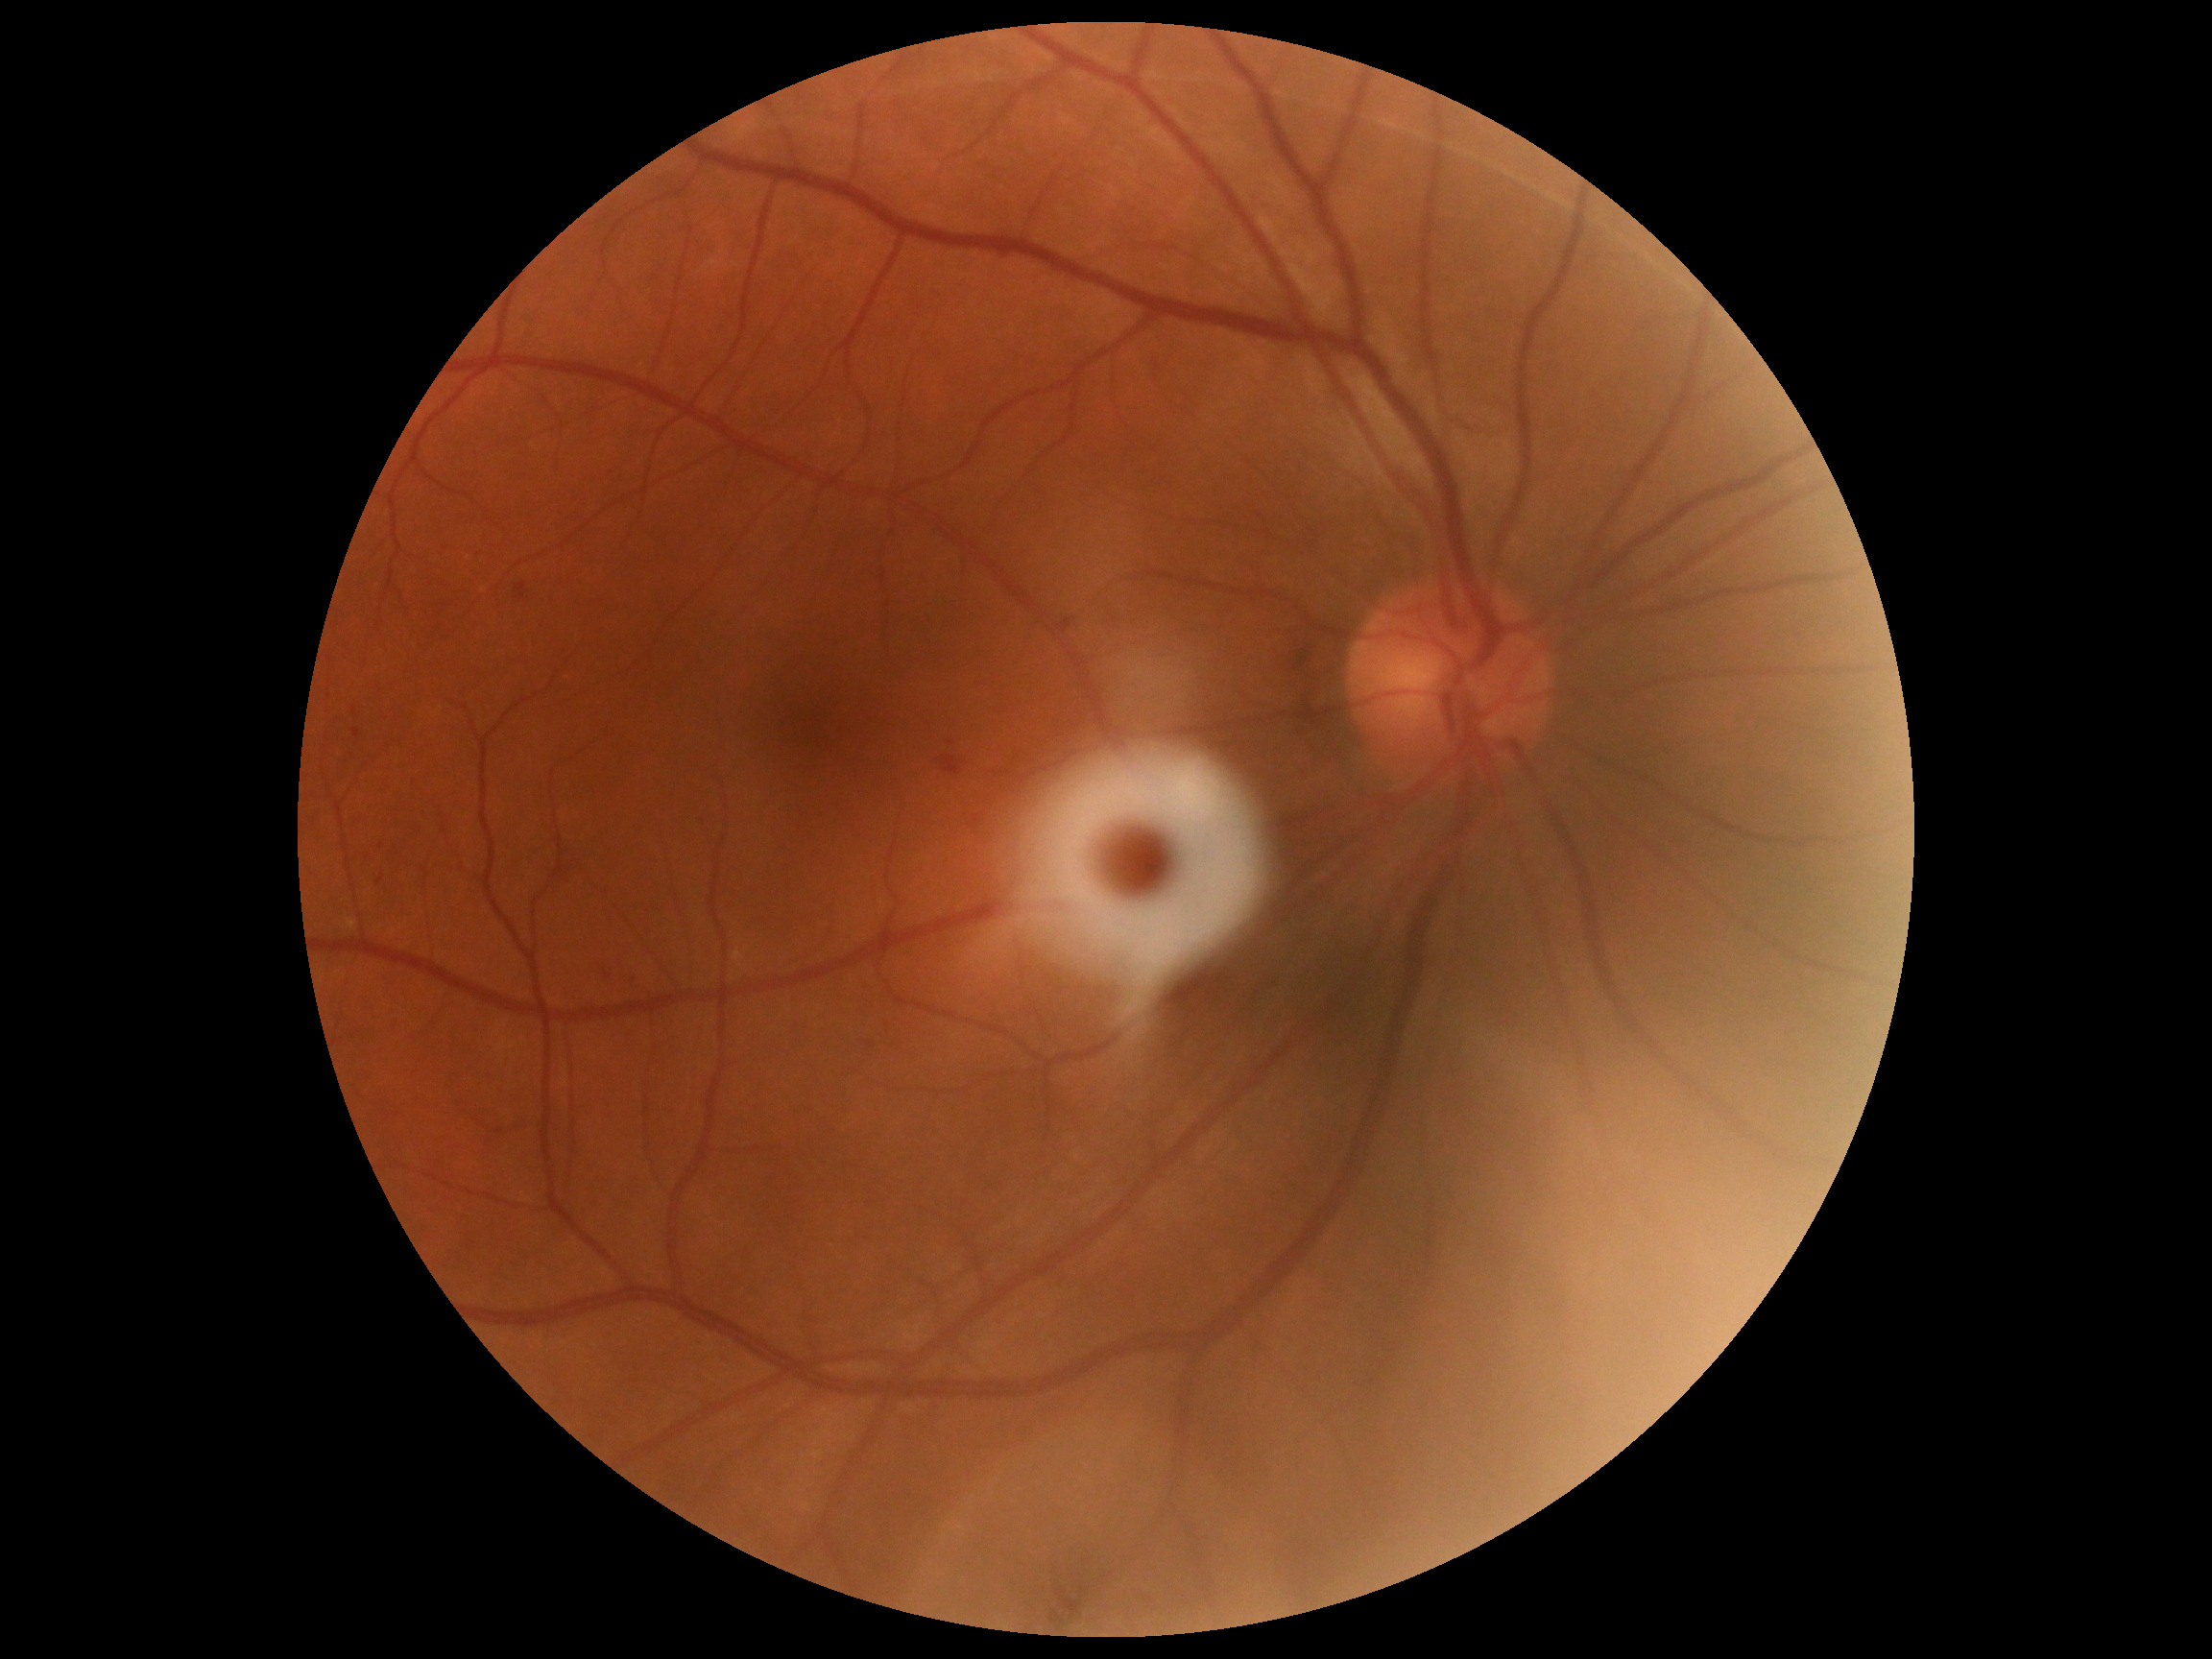
diabetic retinopathy (DR) = 2.